CFP; 2352 by 1568 pixels; 45° FOV — 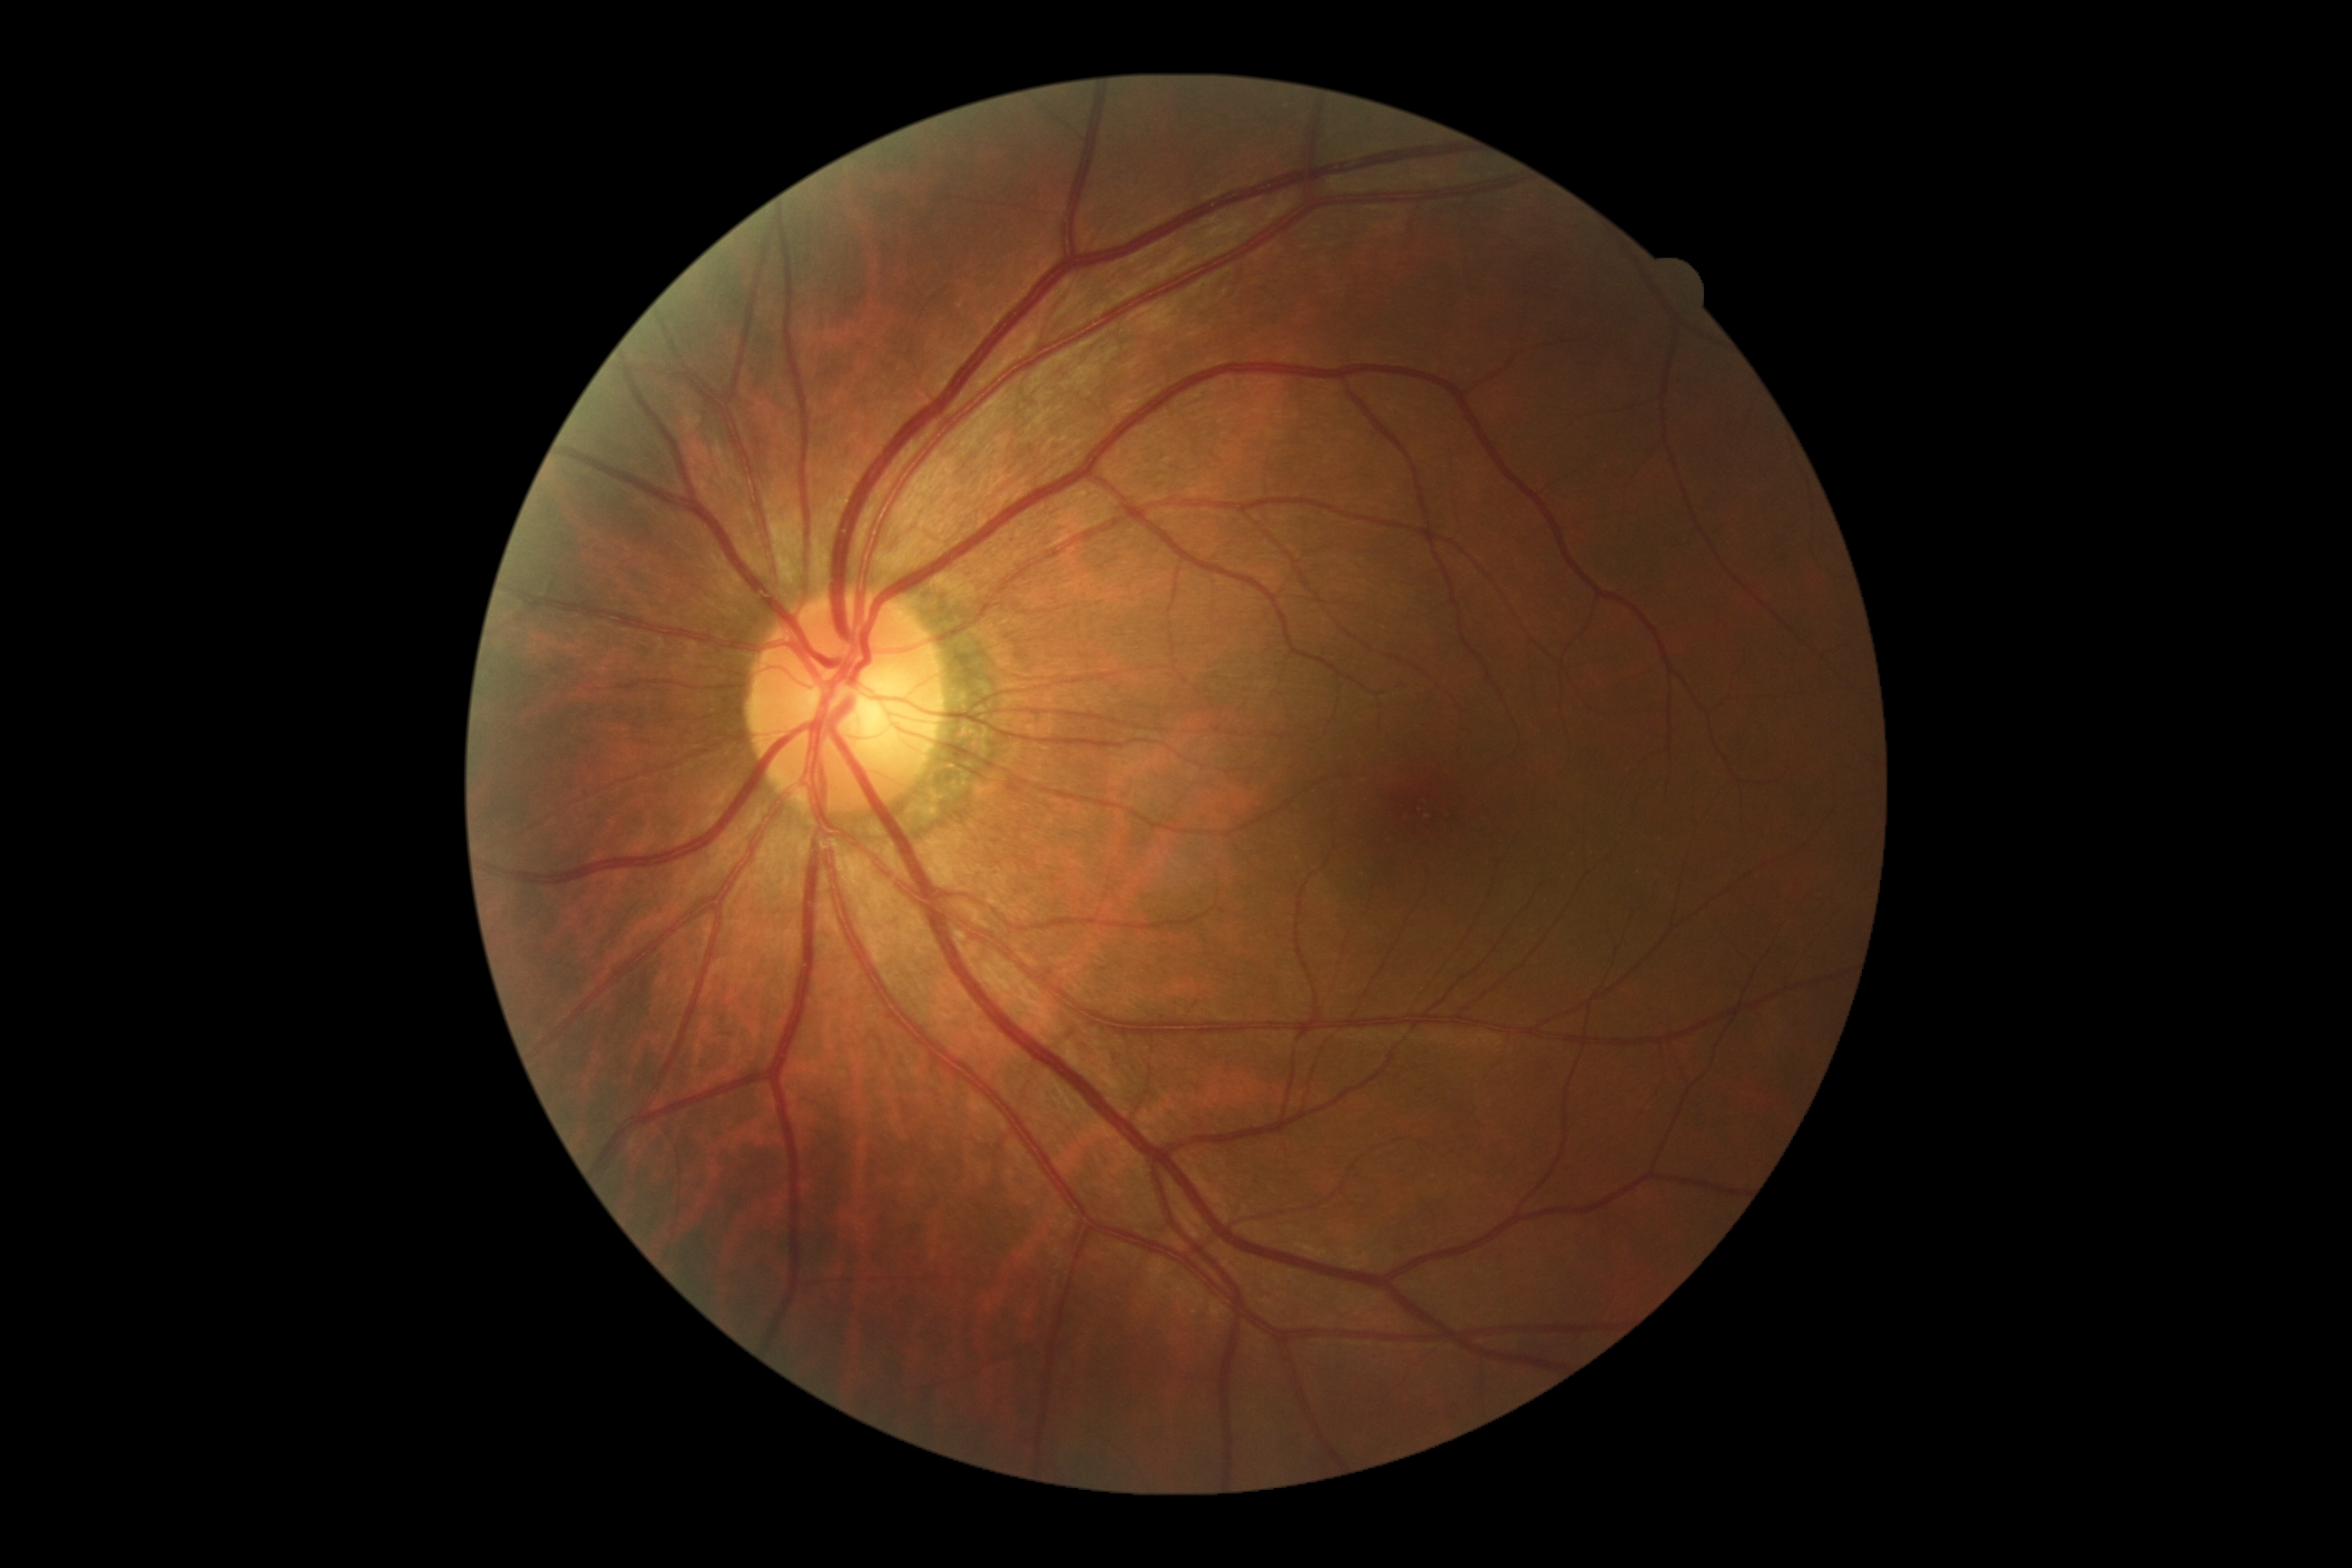
- DR grade — 0/4
- DR impression — no DR findings